Wide-field contact fundus photograph of an infant. Camera: Phoenix ICON (100° FOV):
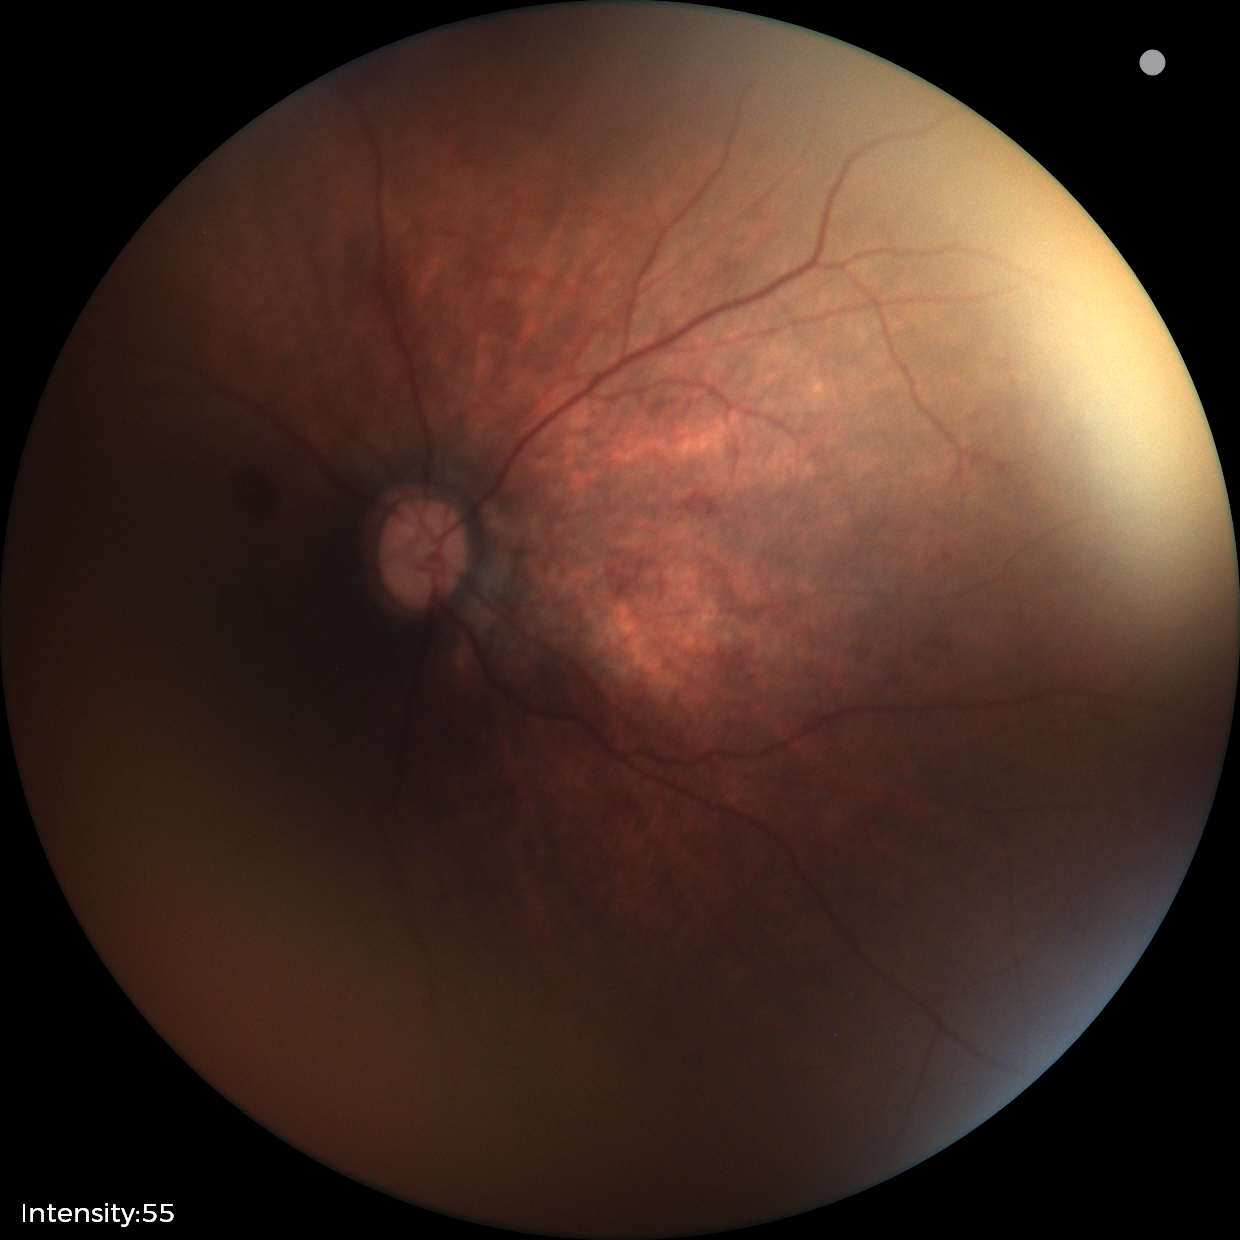

Screening examination consistent with retinal hemorrhages.